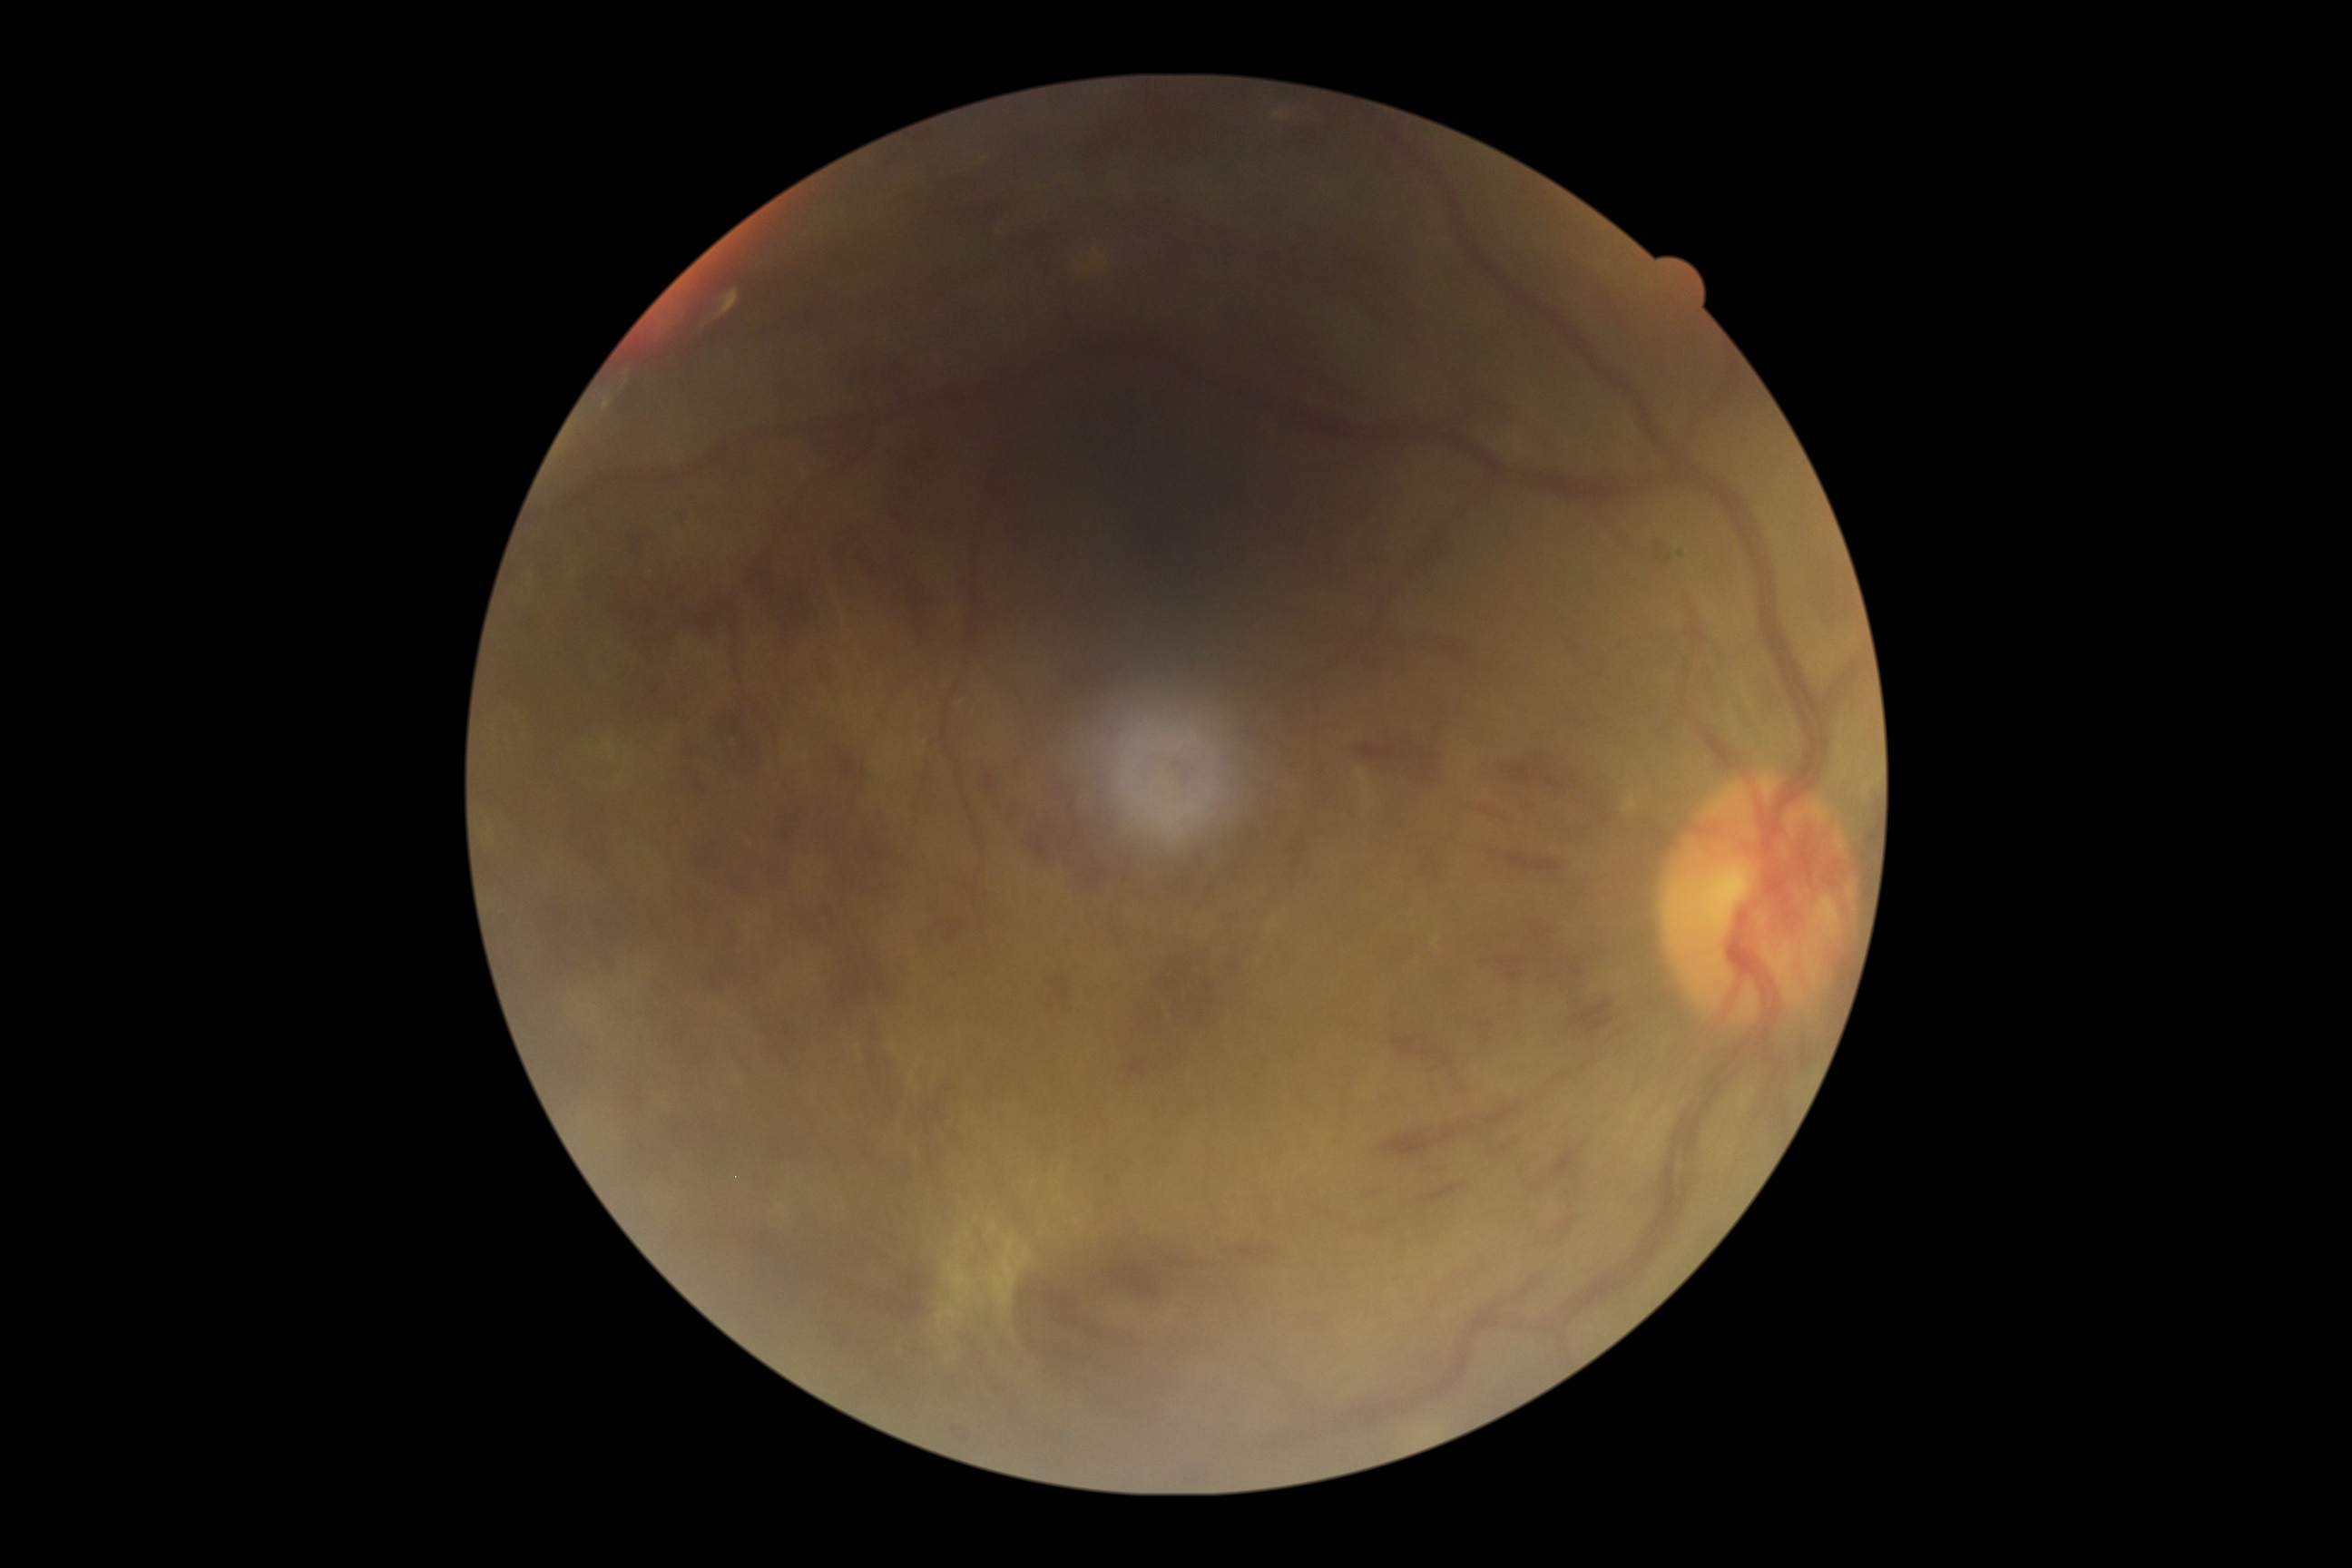
Retinopathy: 4 — neovascularization and/or vitreous/pre-retinal hemorrhage.